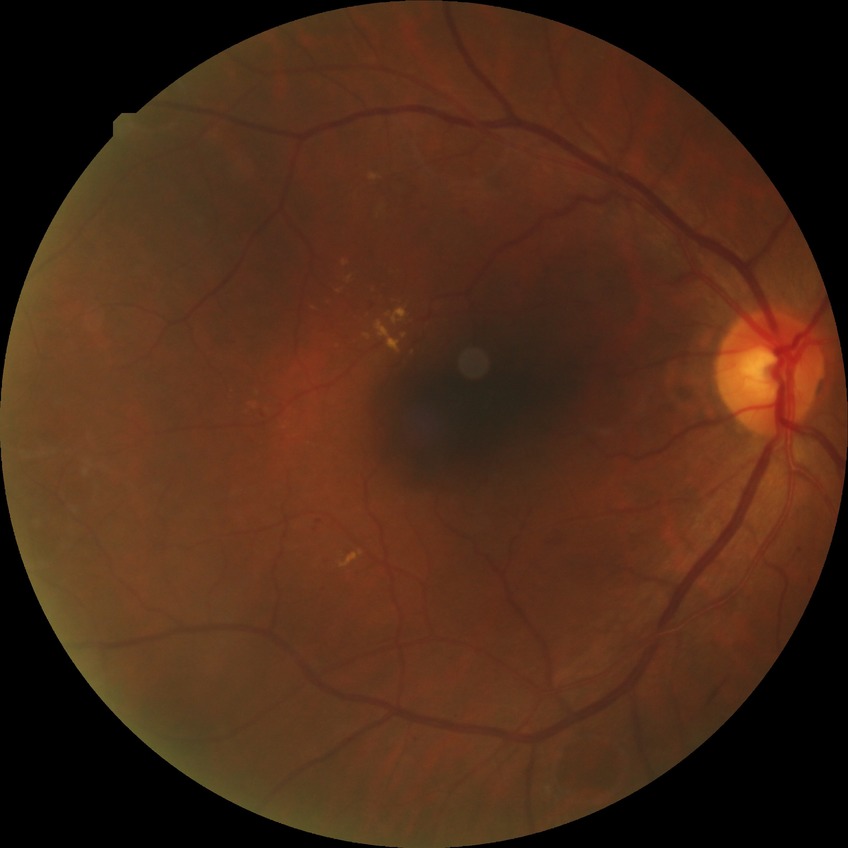
Diabetic retinopathy stage: simple diabetic retinopathy.